Pediatric wide-field fundus photograph · 640 x 480 pixels:
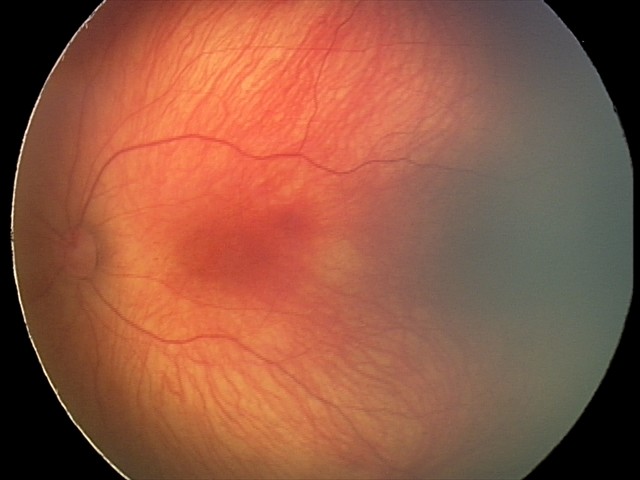 Screening series with retinal hemorrhages.